Acquired with a Remidio smartphone fundus camera; color fundus image
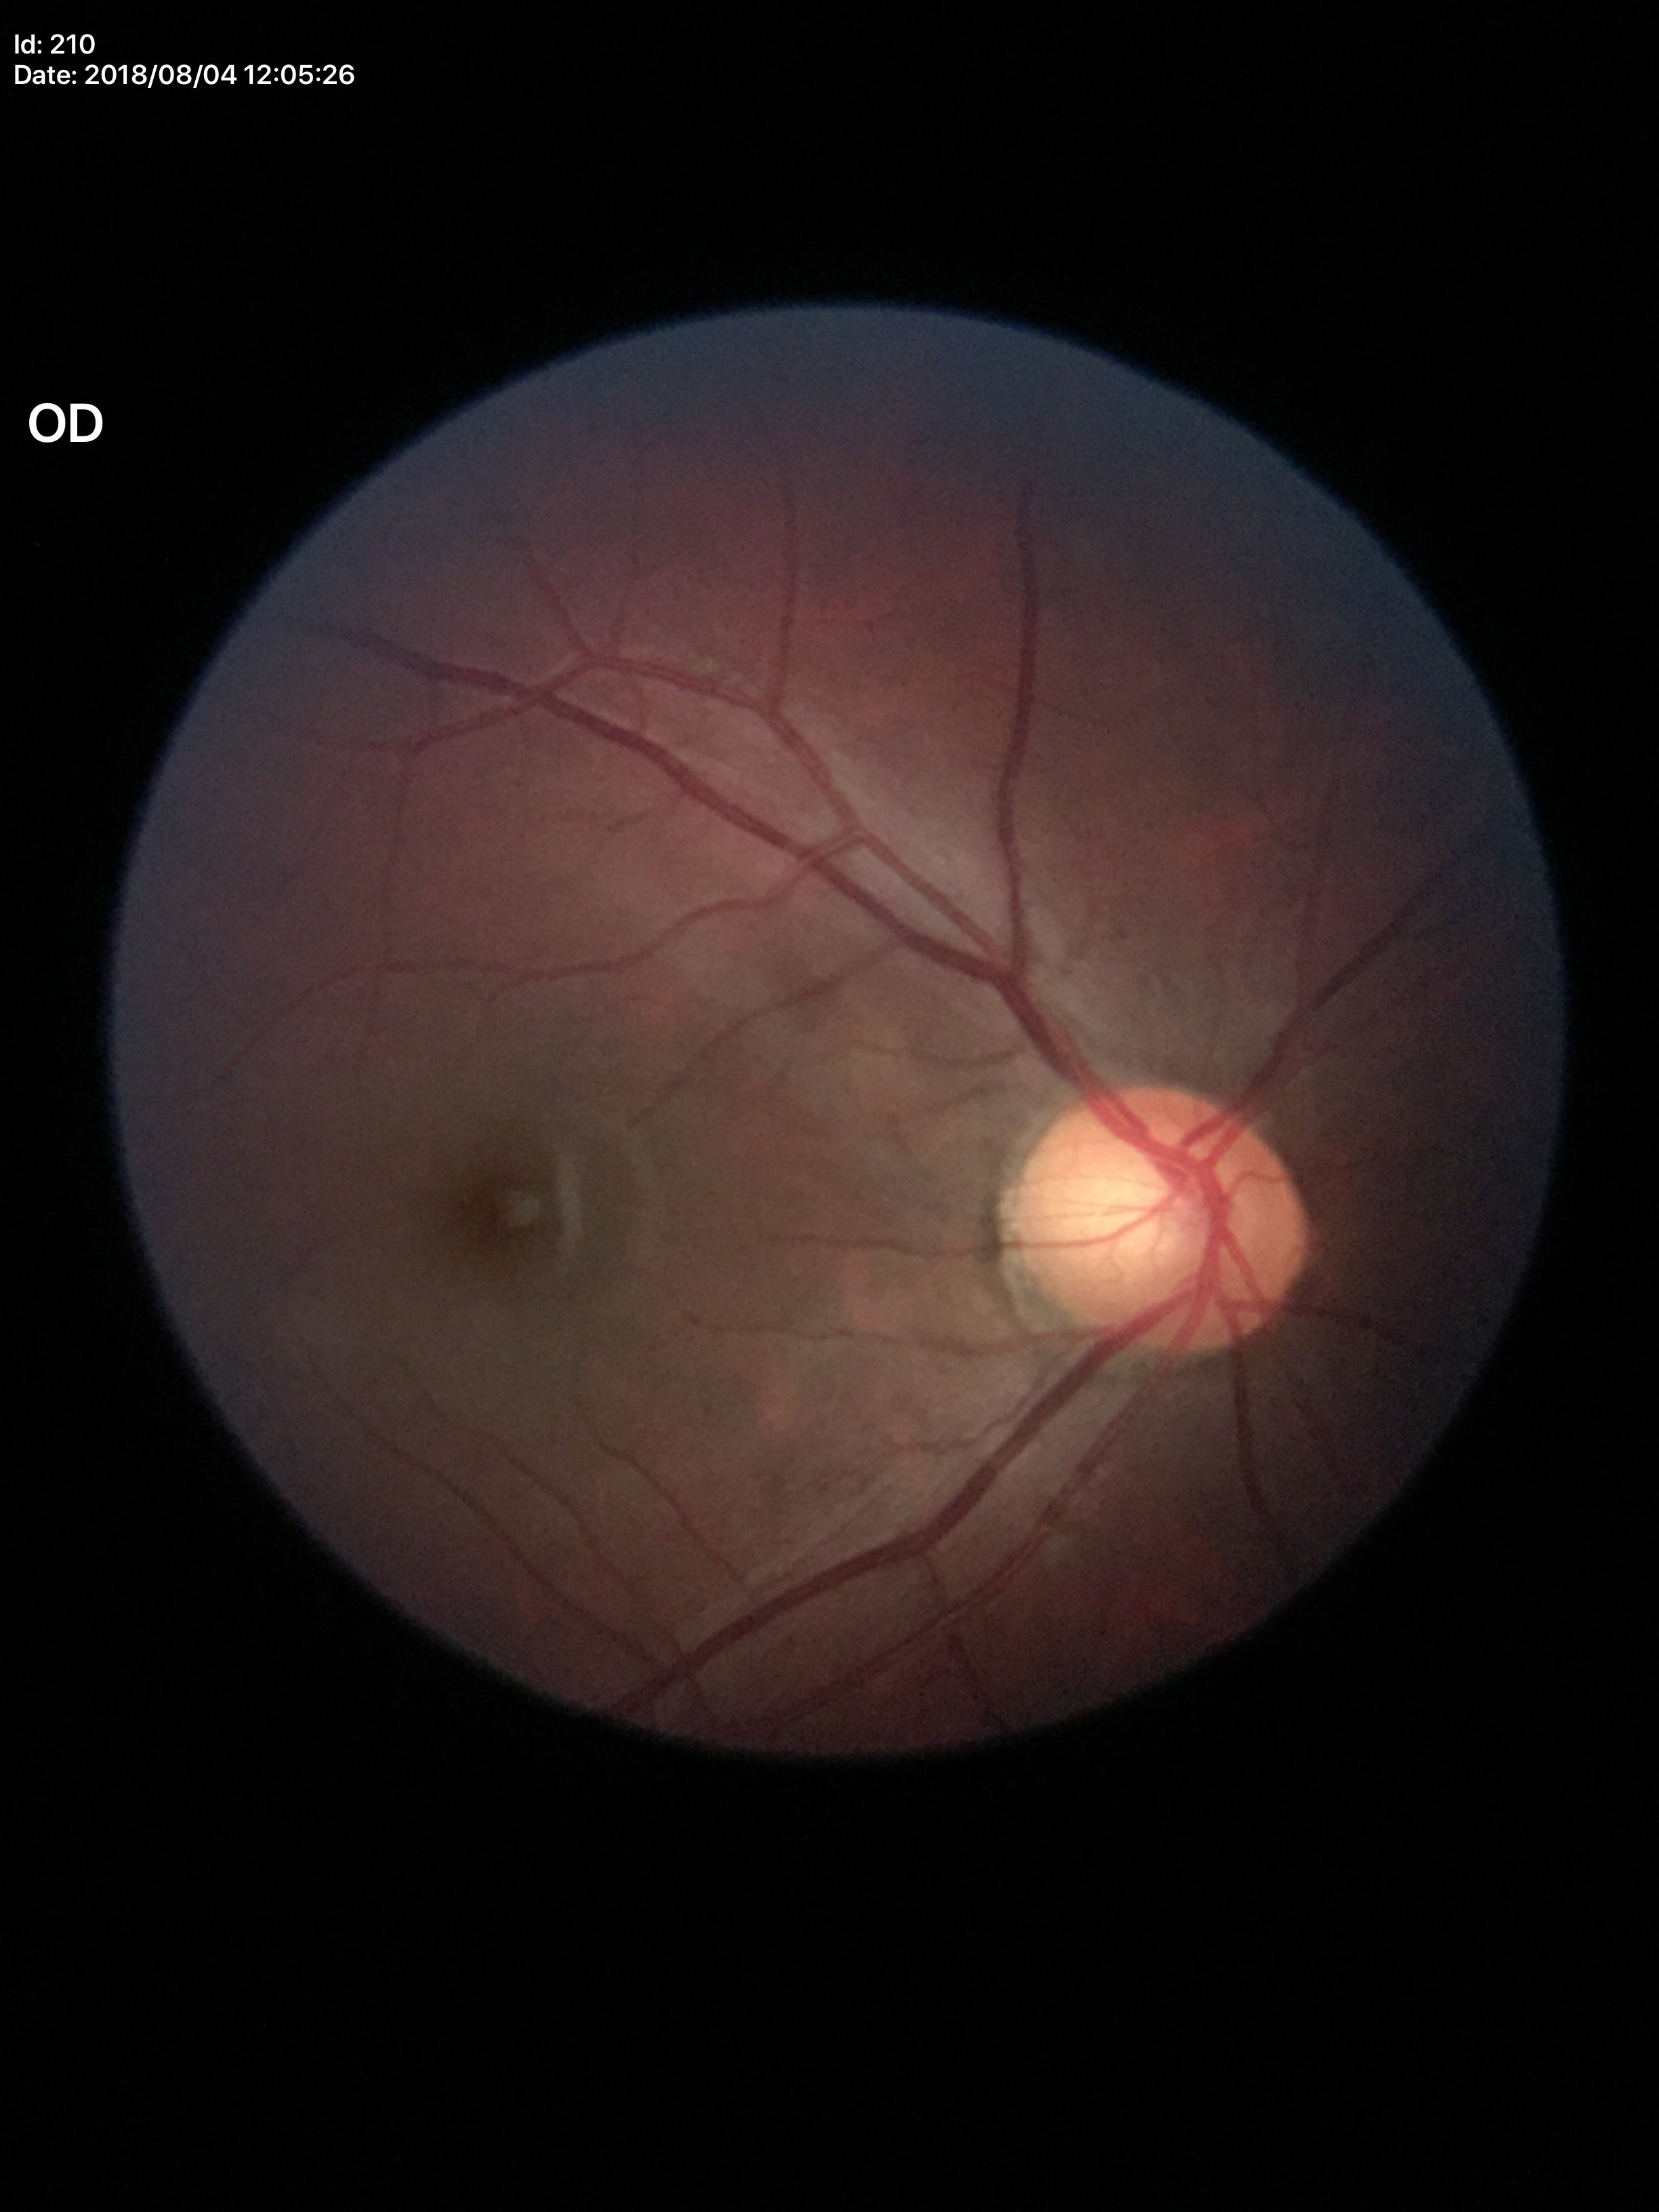 Concerning for glaucoma.
Horizontal cup-disc ratio is 0.63.
Vertical cup-to-disc ratio: 0.63.